Retinal fundus photograph.
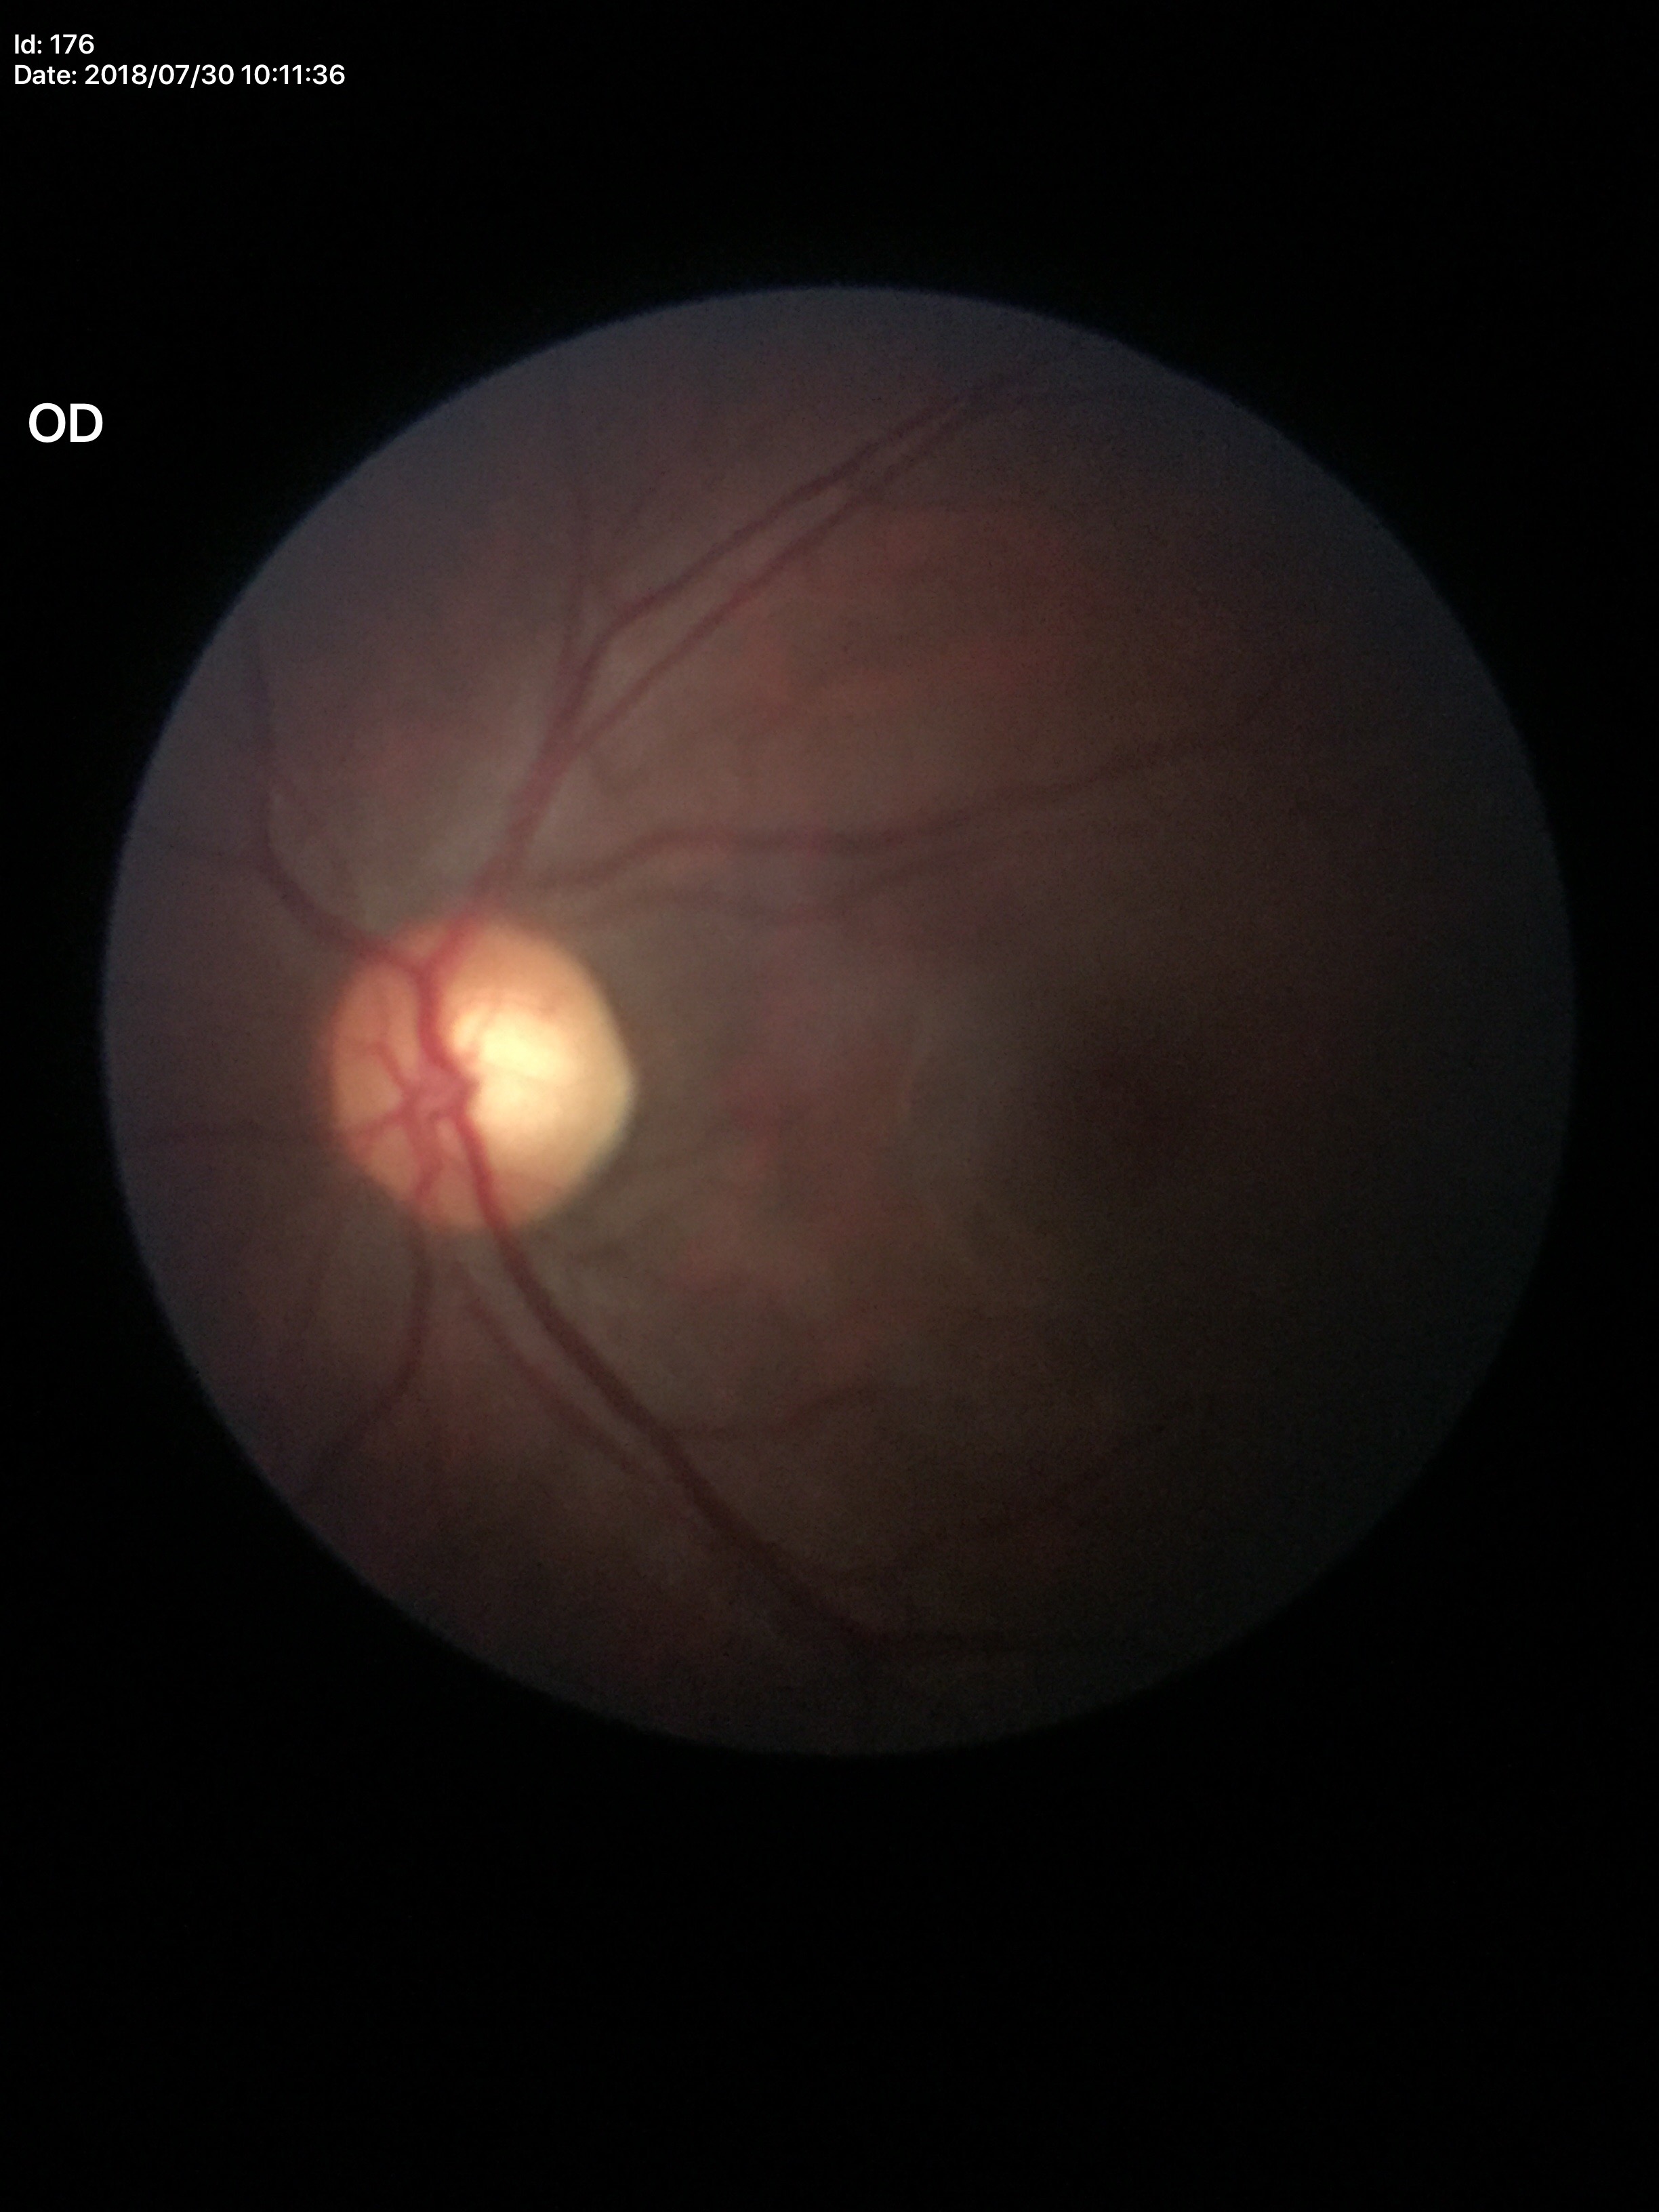 Glaucoma evaluation: negative.
Vertical cup-to-disc ratio of 0.59.